Color fundus photograph — 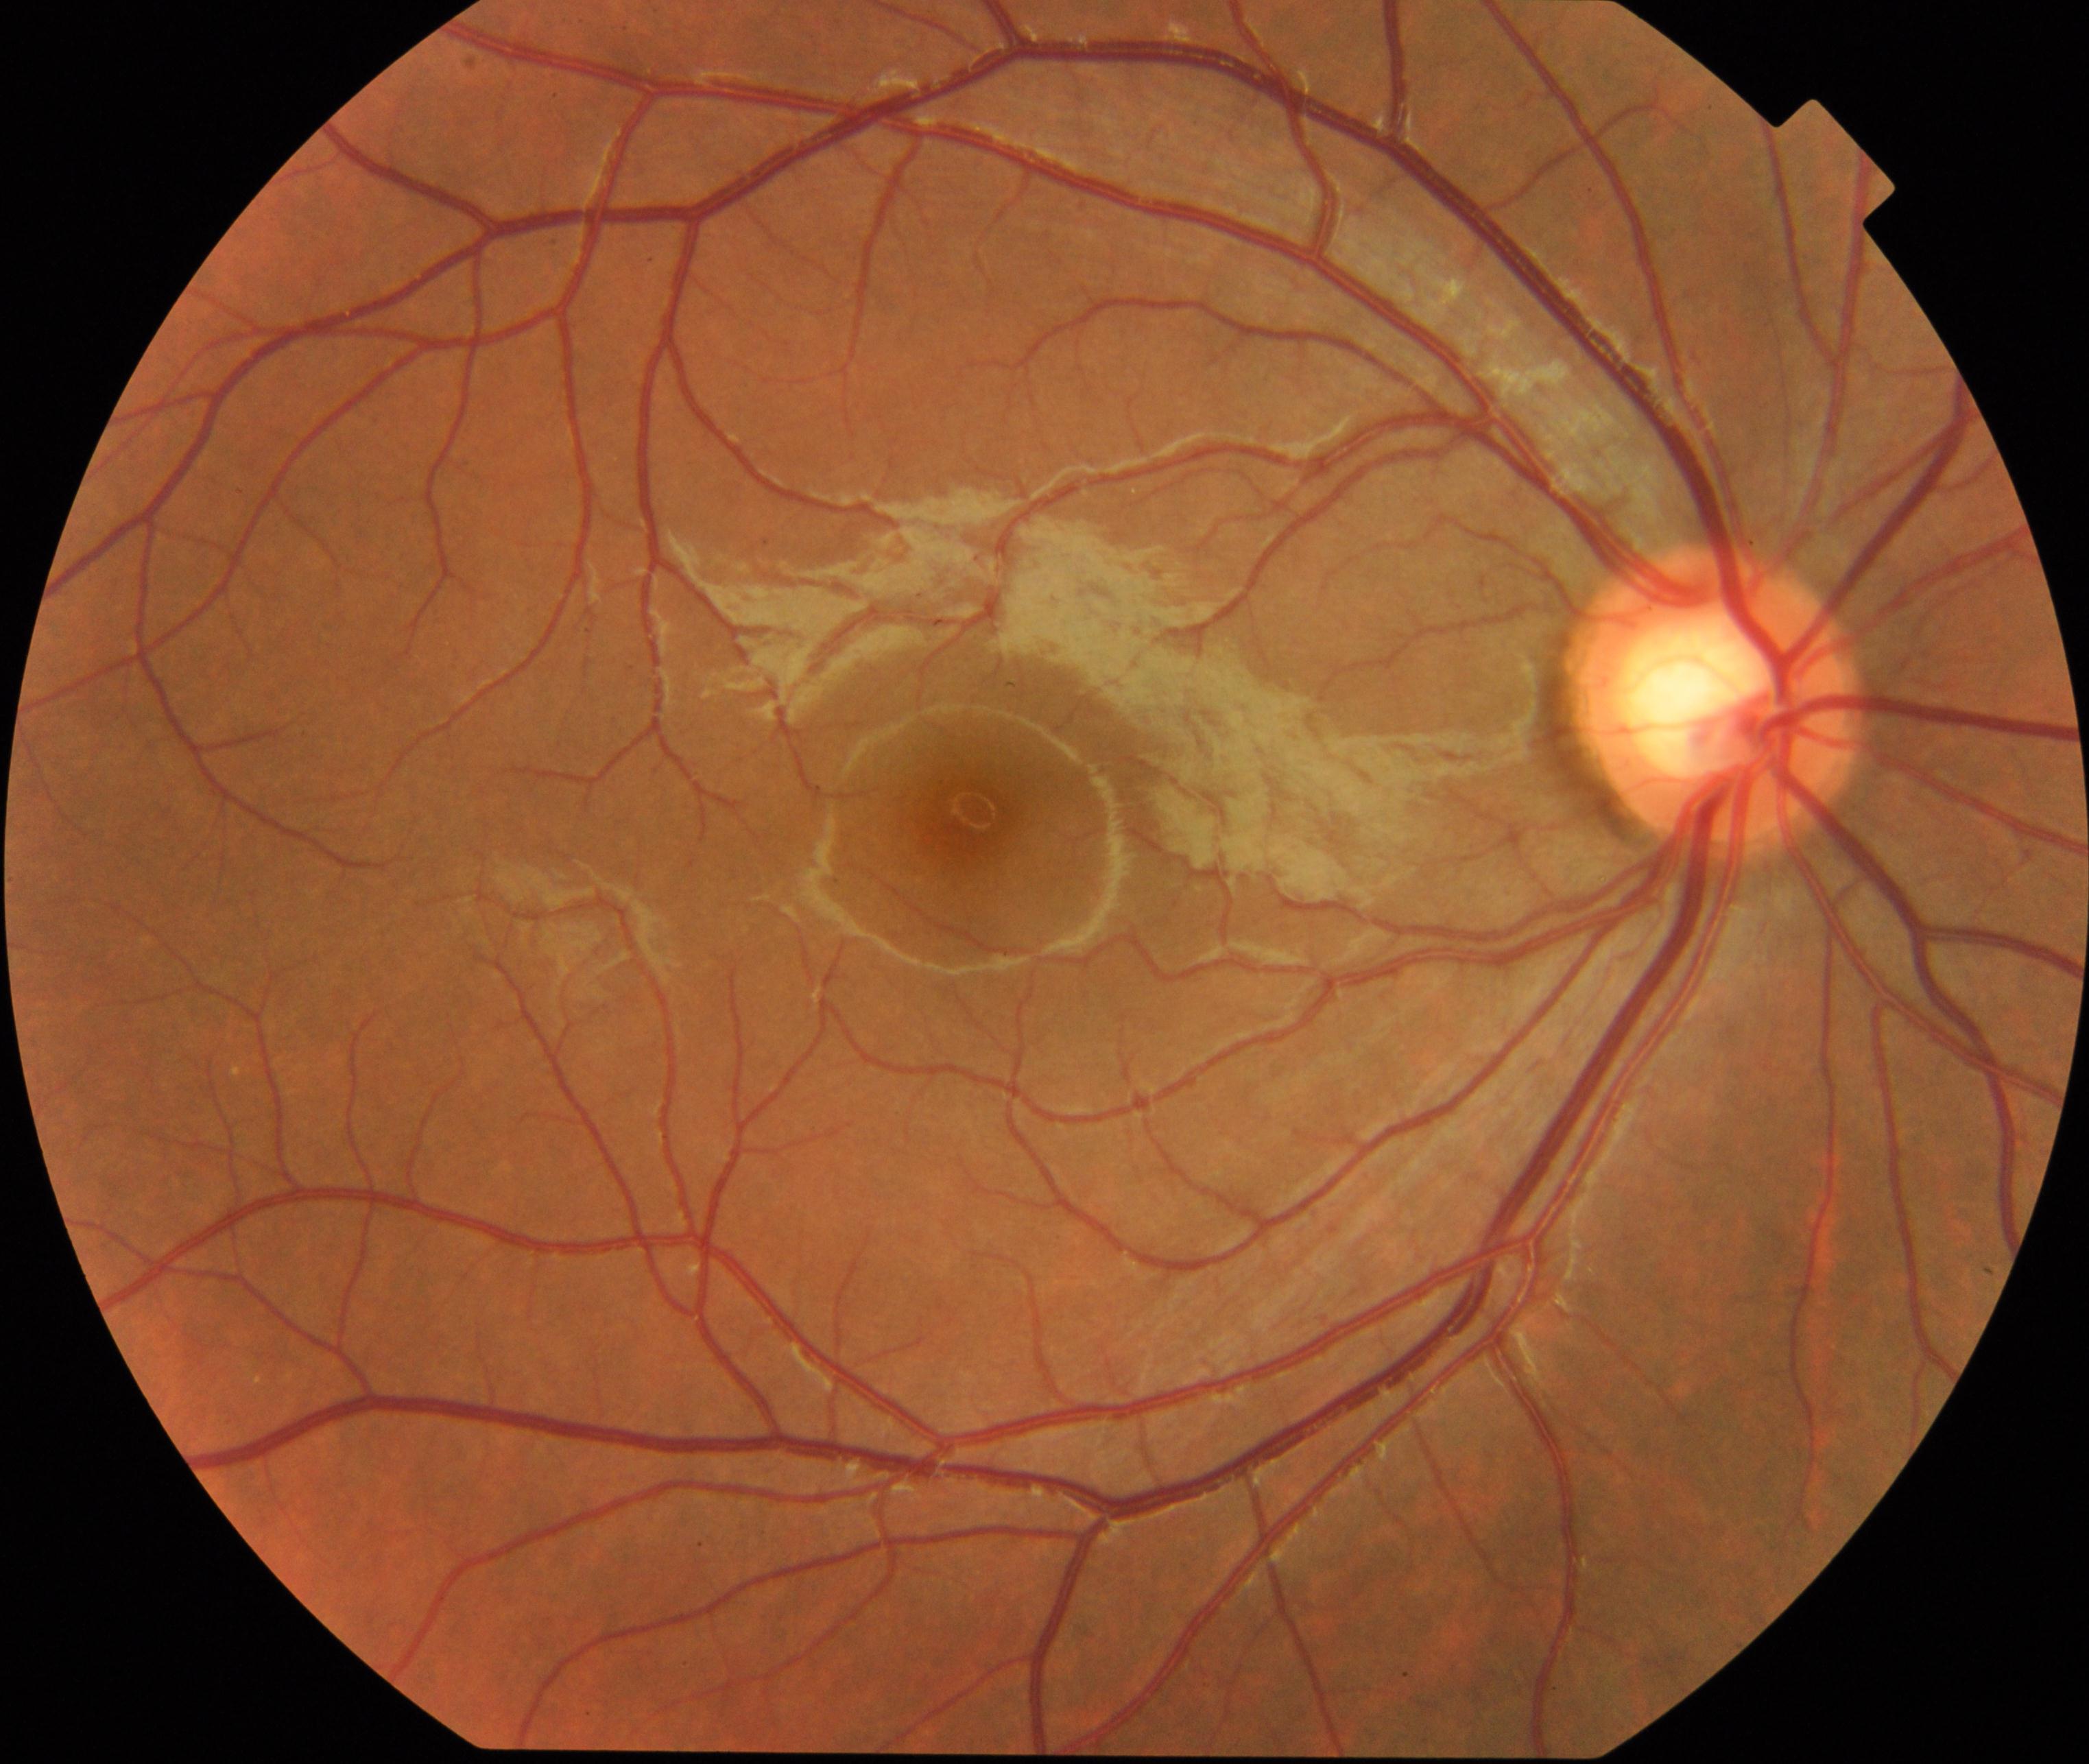
There is evidence of large optic cup. Characterized by cup-to-disc ratio greater than 0.5, with a pink neuroretinal rim following the ISNT rule, without notching or bayoneting of vessels.